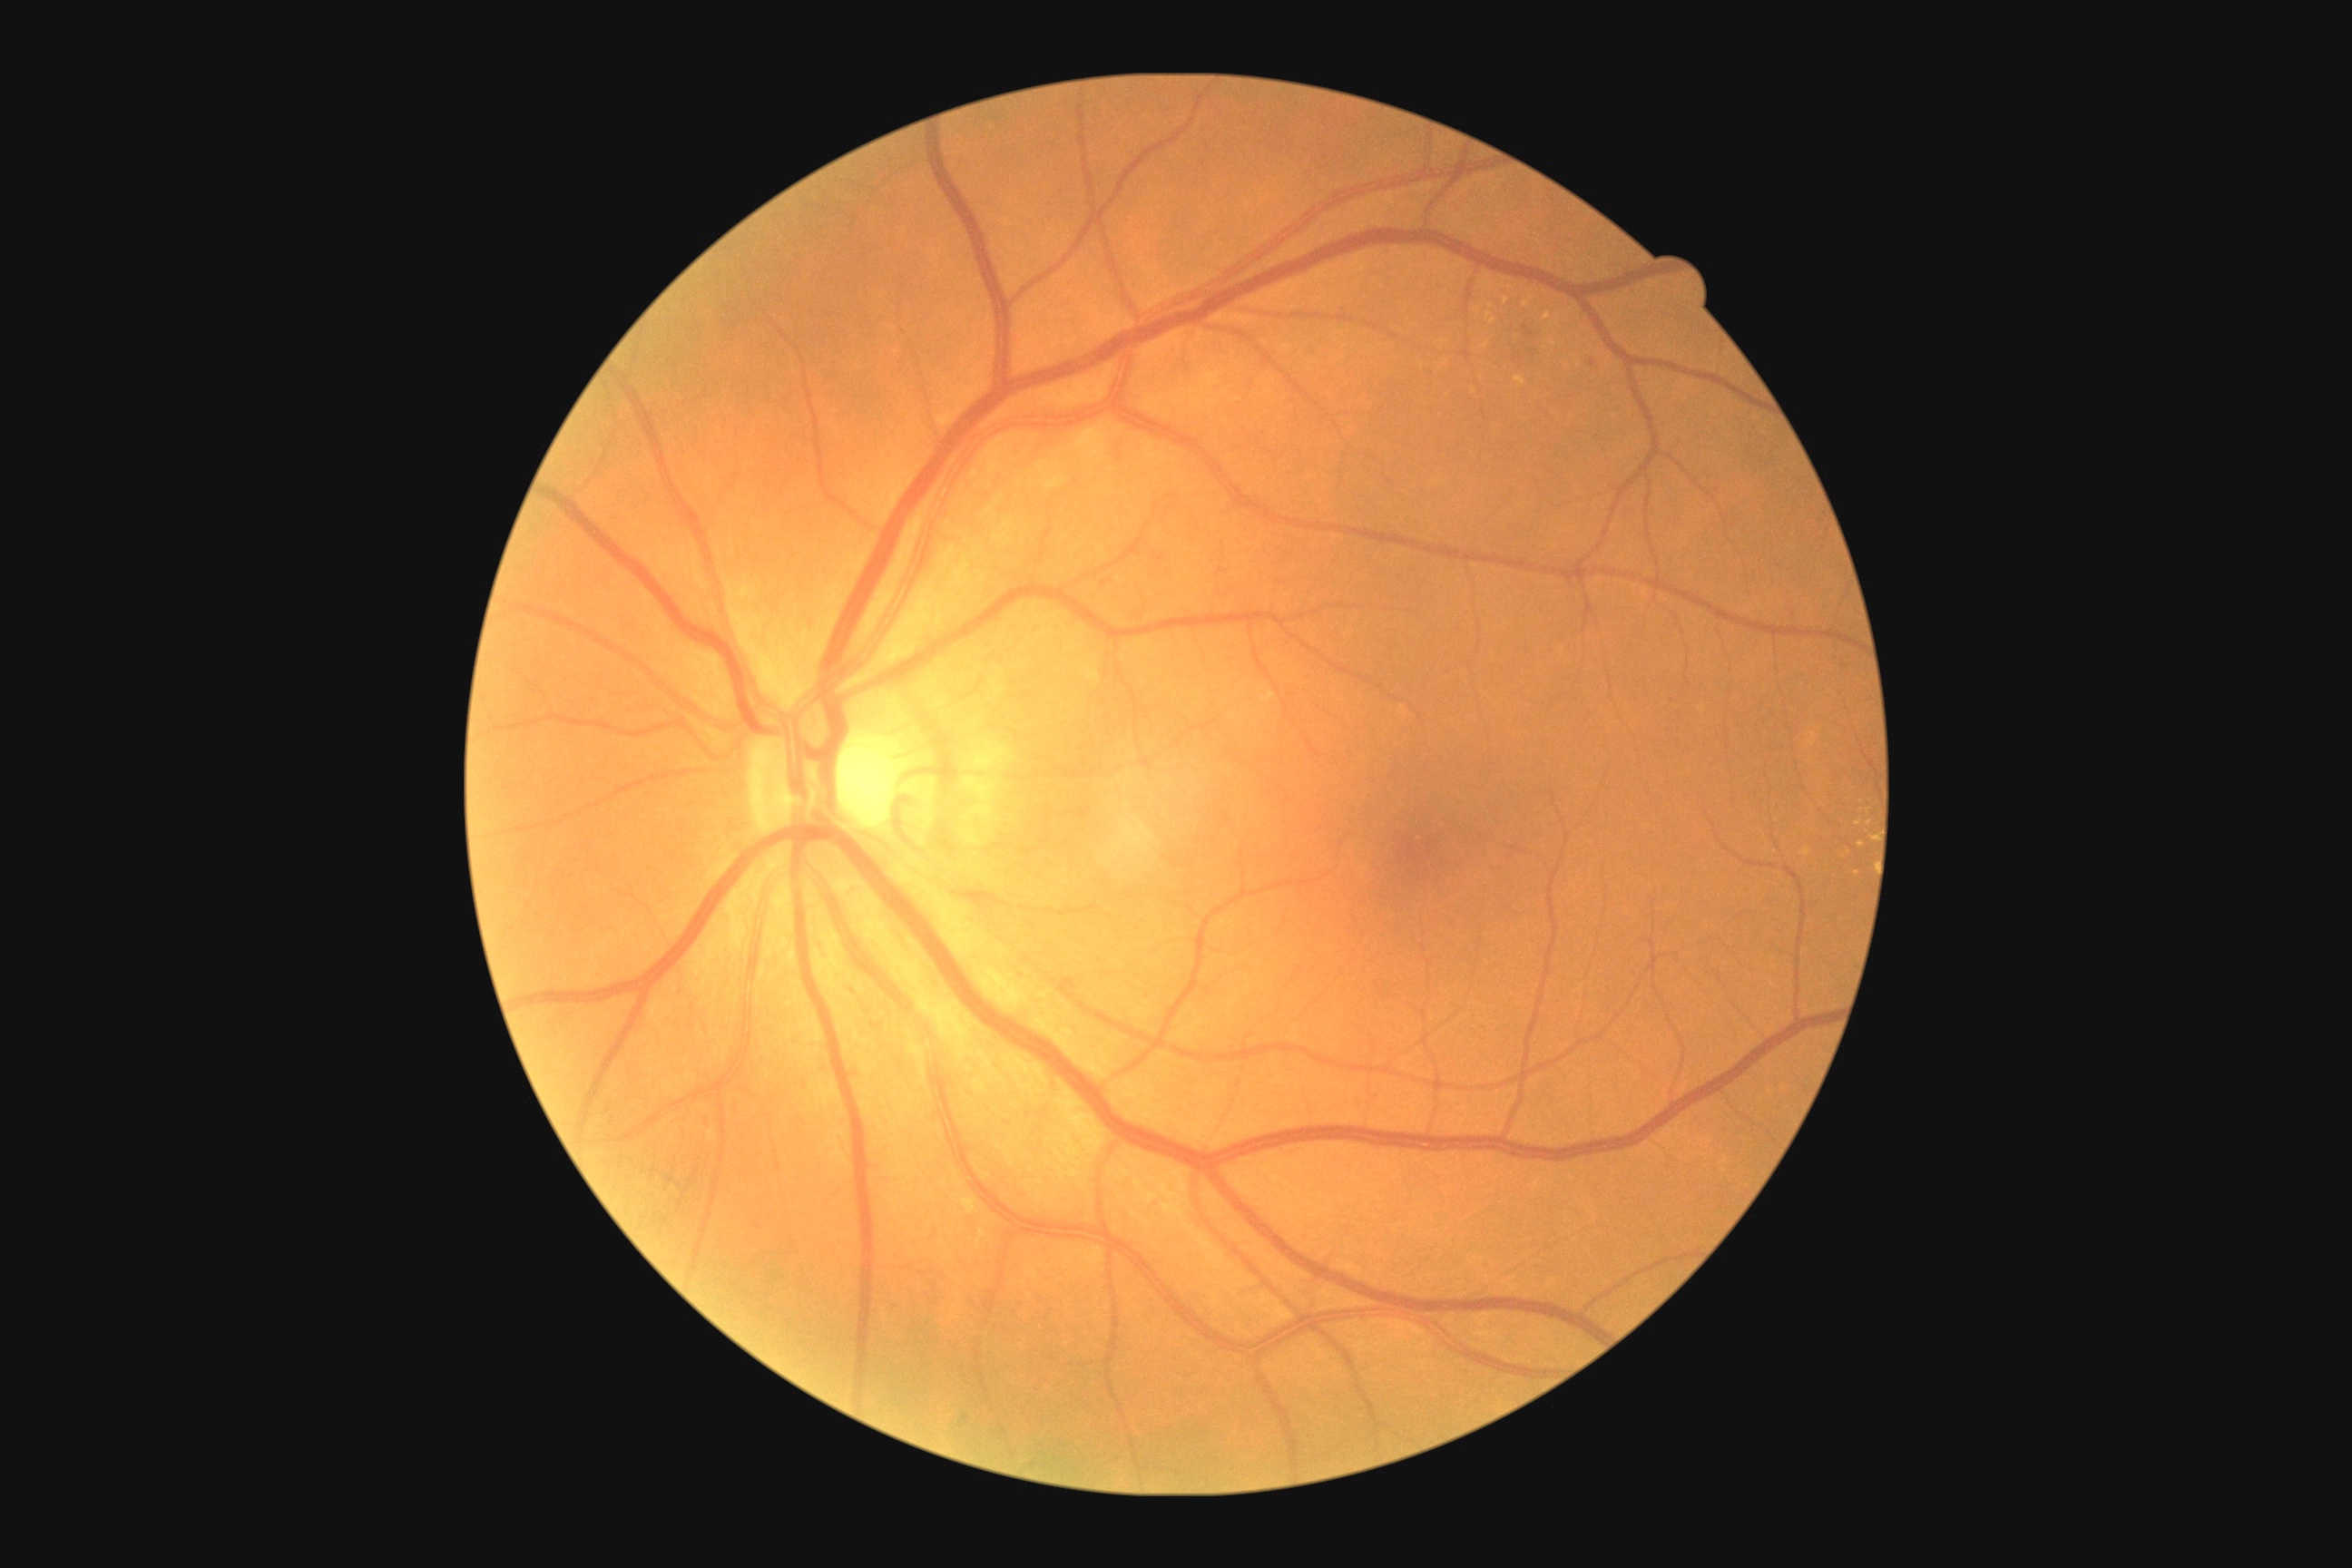

Retinopathy is moderate non-proliferative diabetic retinopathy (grade 2); non-proliferative diabetic retinopathy
Selected lesions:
microaneurysms (continued): BBox(1524, 326, 1534, 337) | BBox(1159, 554, 1166, 562) | BBox(1589, 360, 1596, 368)
Additional small microaneurysms near {"x": 1103, "y": 584}
hard exudates (continued): BBox(1500, 279, 1514, 289) | BBox(1088, 672, 1101, 689) | BBox(1262, 691, 1275, 703) | BBox(1549, 340, 1558, 348)
Additional small hard exudates near {"x": 1463, "y": 266} | {"x": 1870, "y": 823} | {"x": 1559, "y": 320} | {"x": 1478, "y": 312} | {"x": 1858, "y": 825} | {"x": 1547, "y": 316} | {"x": 1493, "y": 321}
soft exudates: none
hemorrhages: none